Mydriatic (tropicamide and phenylephrine) · fundus photo:
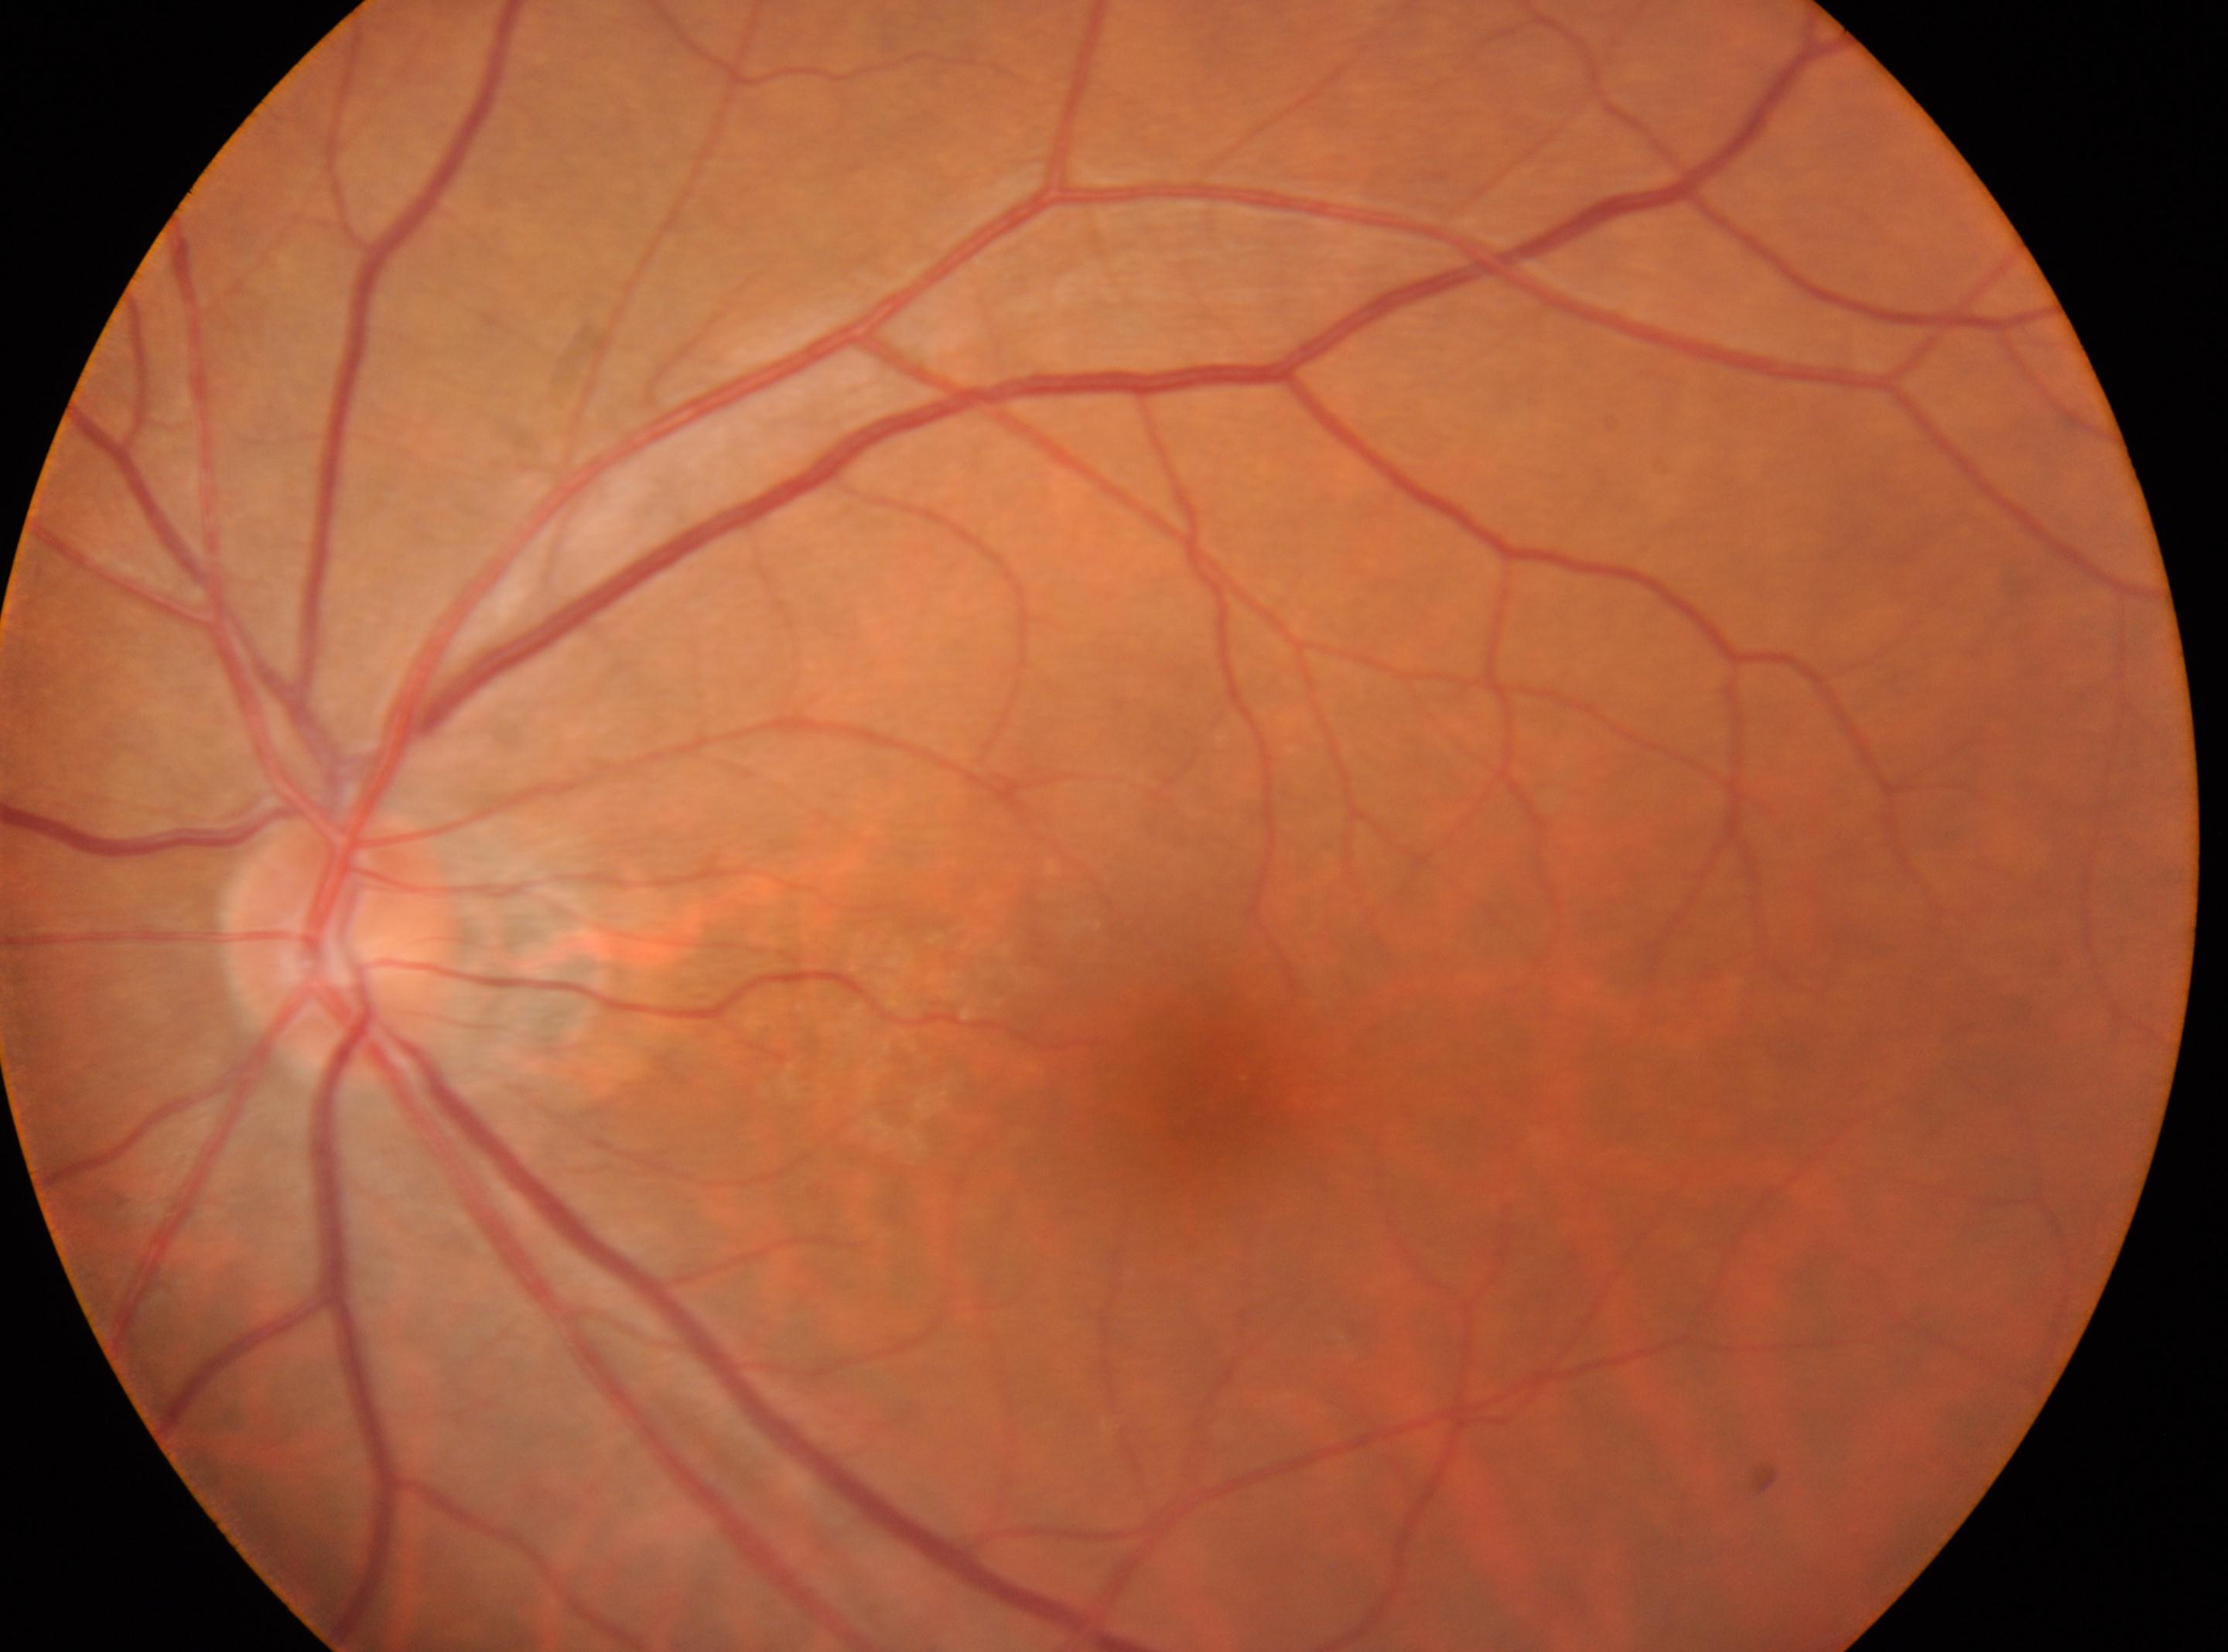 Q: Any diabetic retinopathy?
A: No apparent diabetic retinopathy
Q: DR stage?
A: 0
Q: Locate the optic disc.
A: (x: 345, y: 947)
Q: What is the laterality?
A: oculus sinister
Q: Locate the fovea.
A: (x: 1206, y: 1081)